CFP:
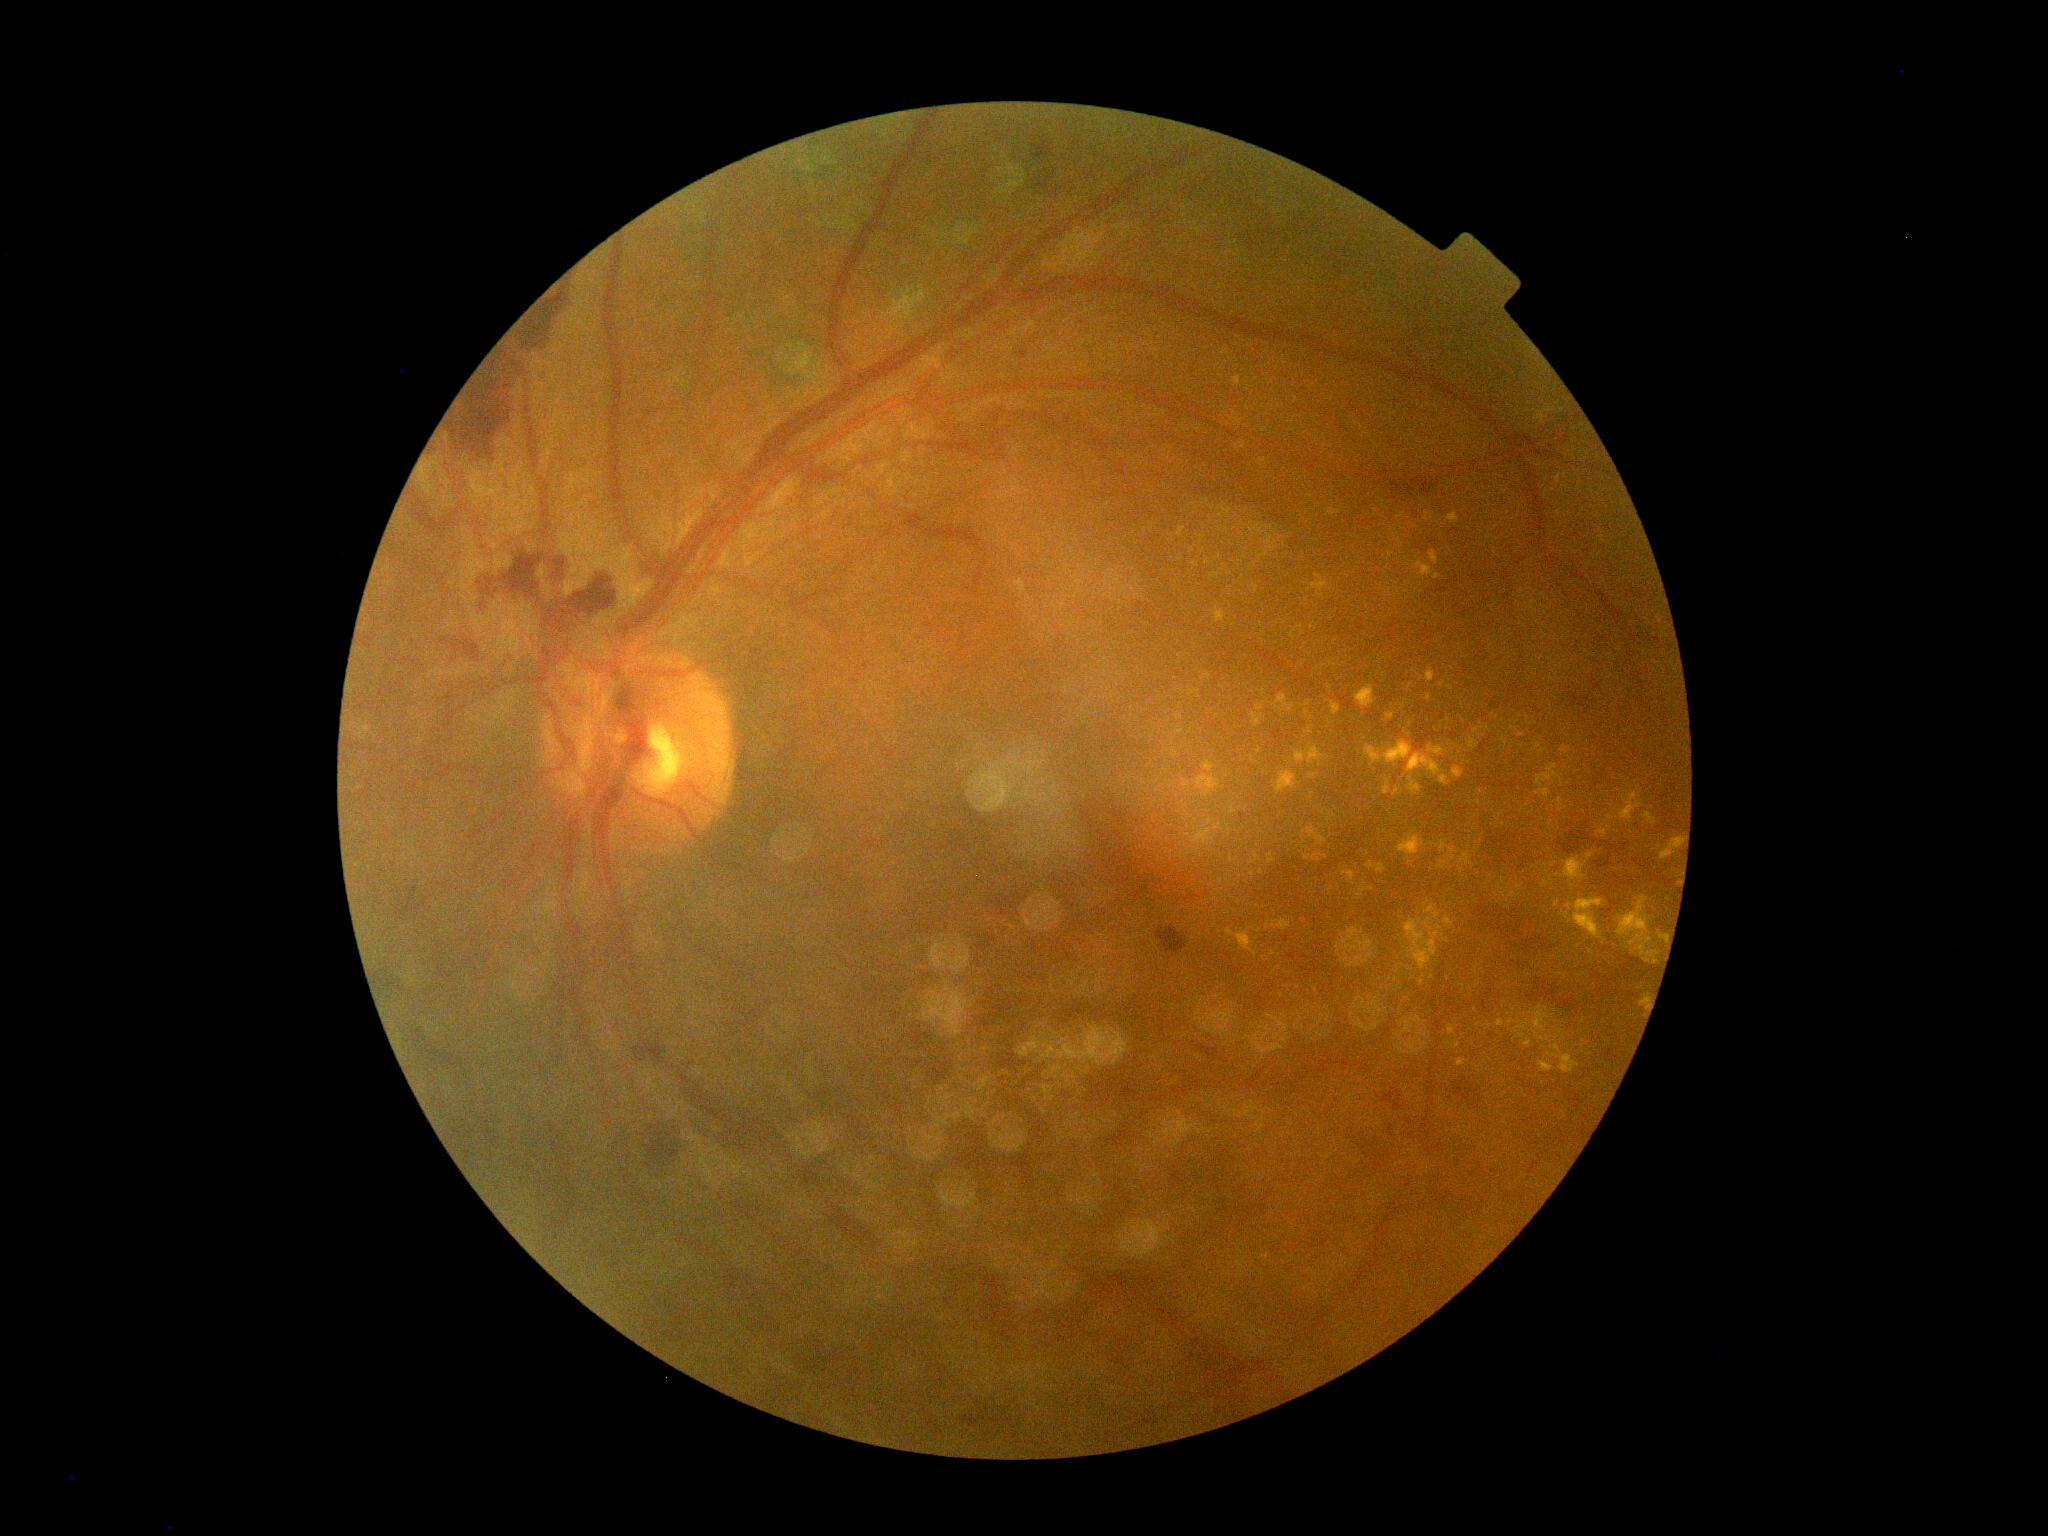 DR@grade 4 (PDR).